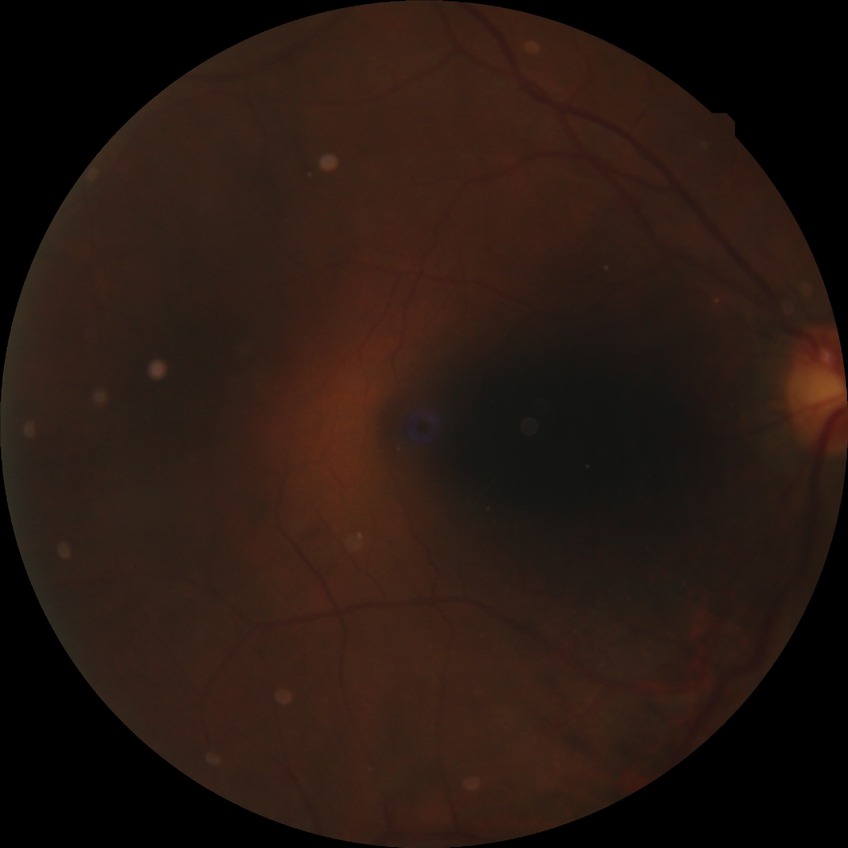 Modified Davis classification is no diabetic retinopathy.